Posterior pole color fundus photograph; NIDEK AFC-230.
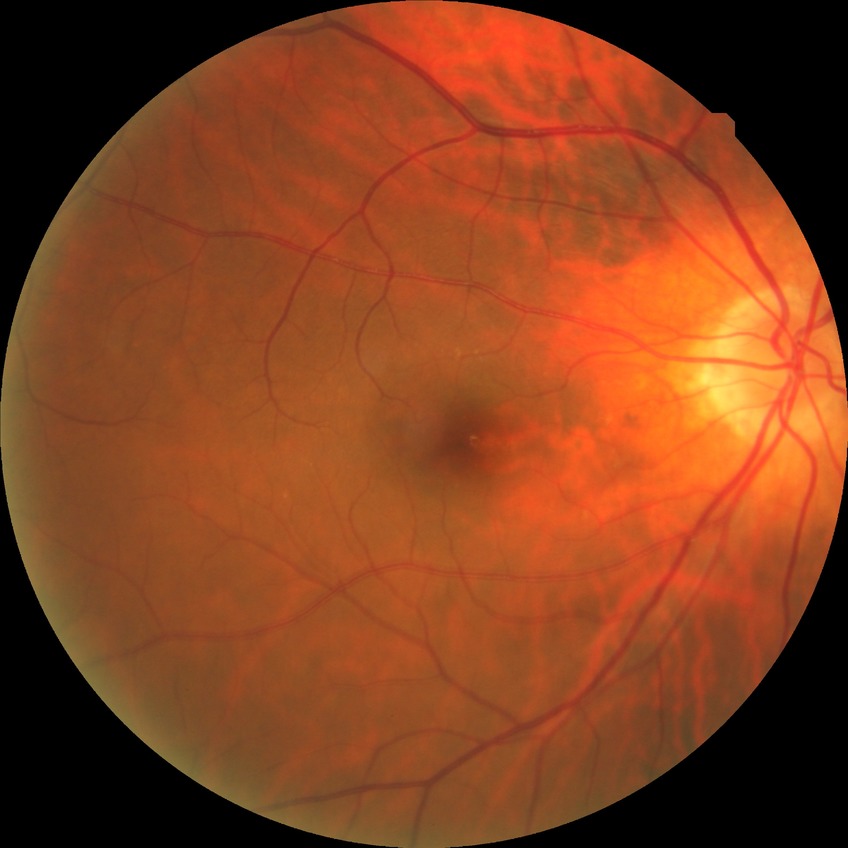
Diabetic retinopathy (DR): NDR (no diabetic retinopathy).